Davis DR grading. No pharmacologic dilation. NIDEK AFC-230 fundus camera. FOV: 45 degrees:
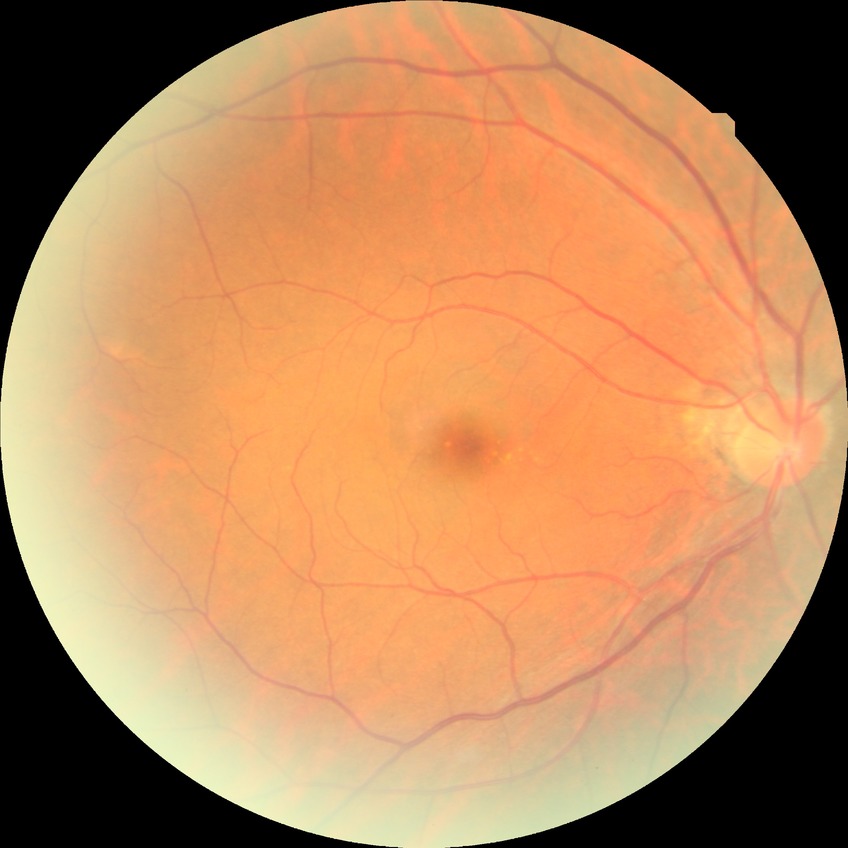

Diabetic retinopathy (DR) is NDR (no diabetic retinopathy).